Color fundus photograph; 2346x1568px:
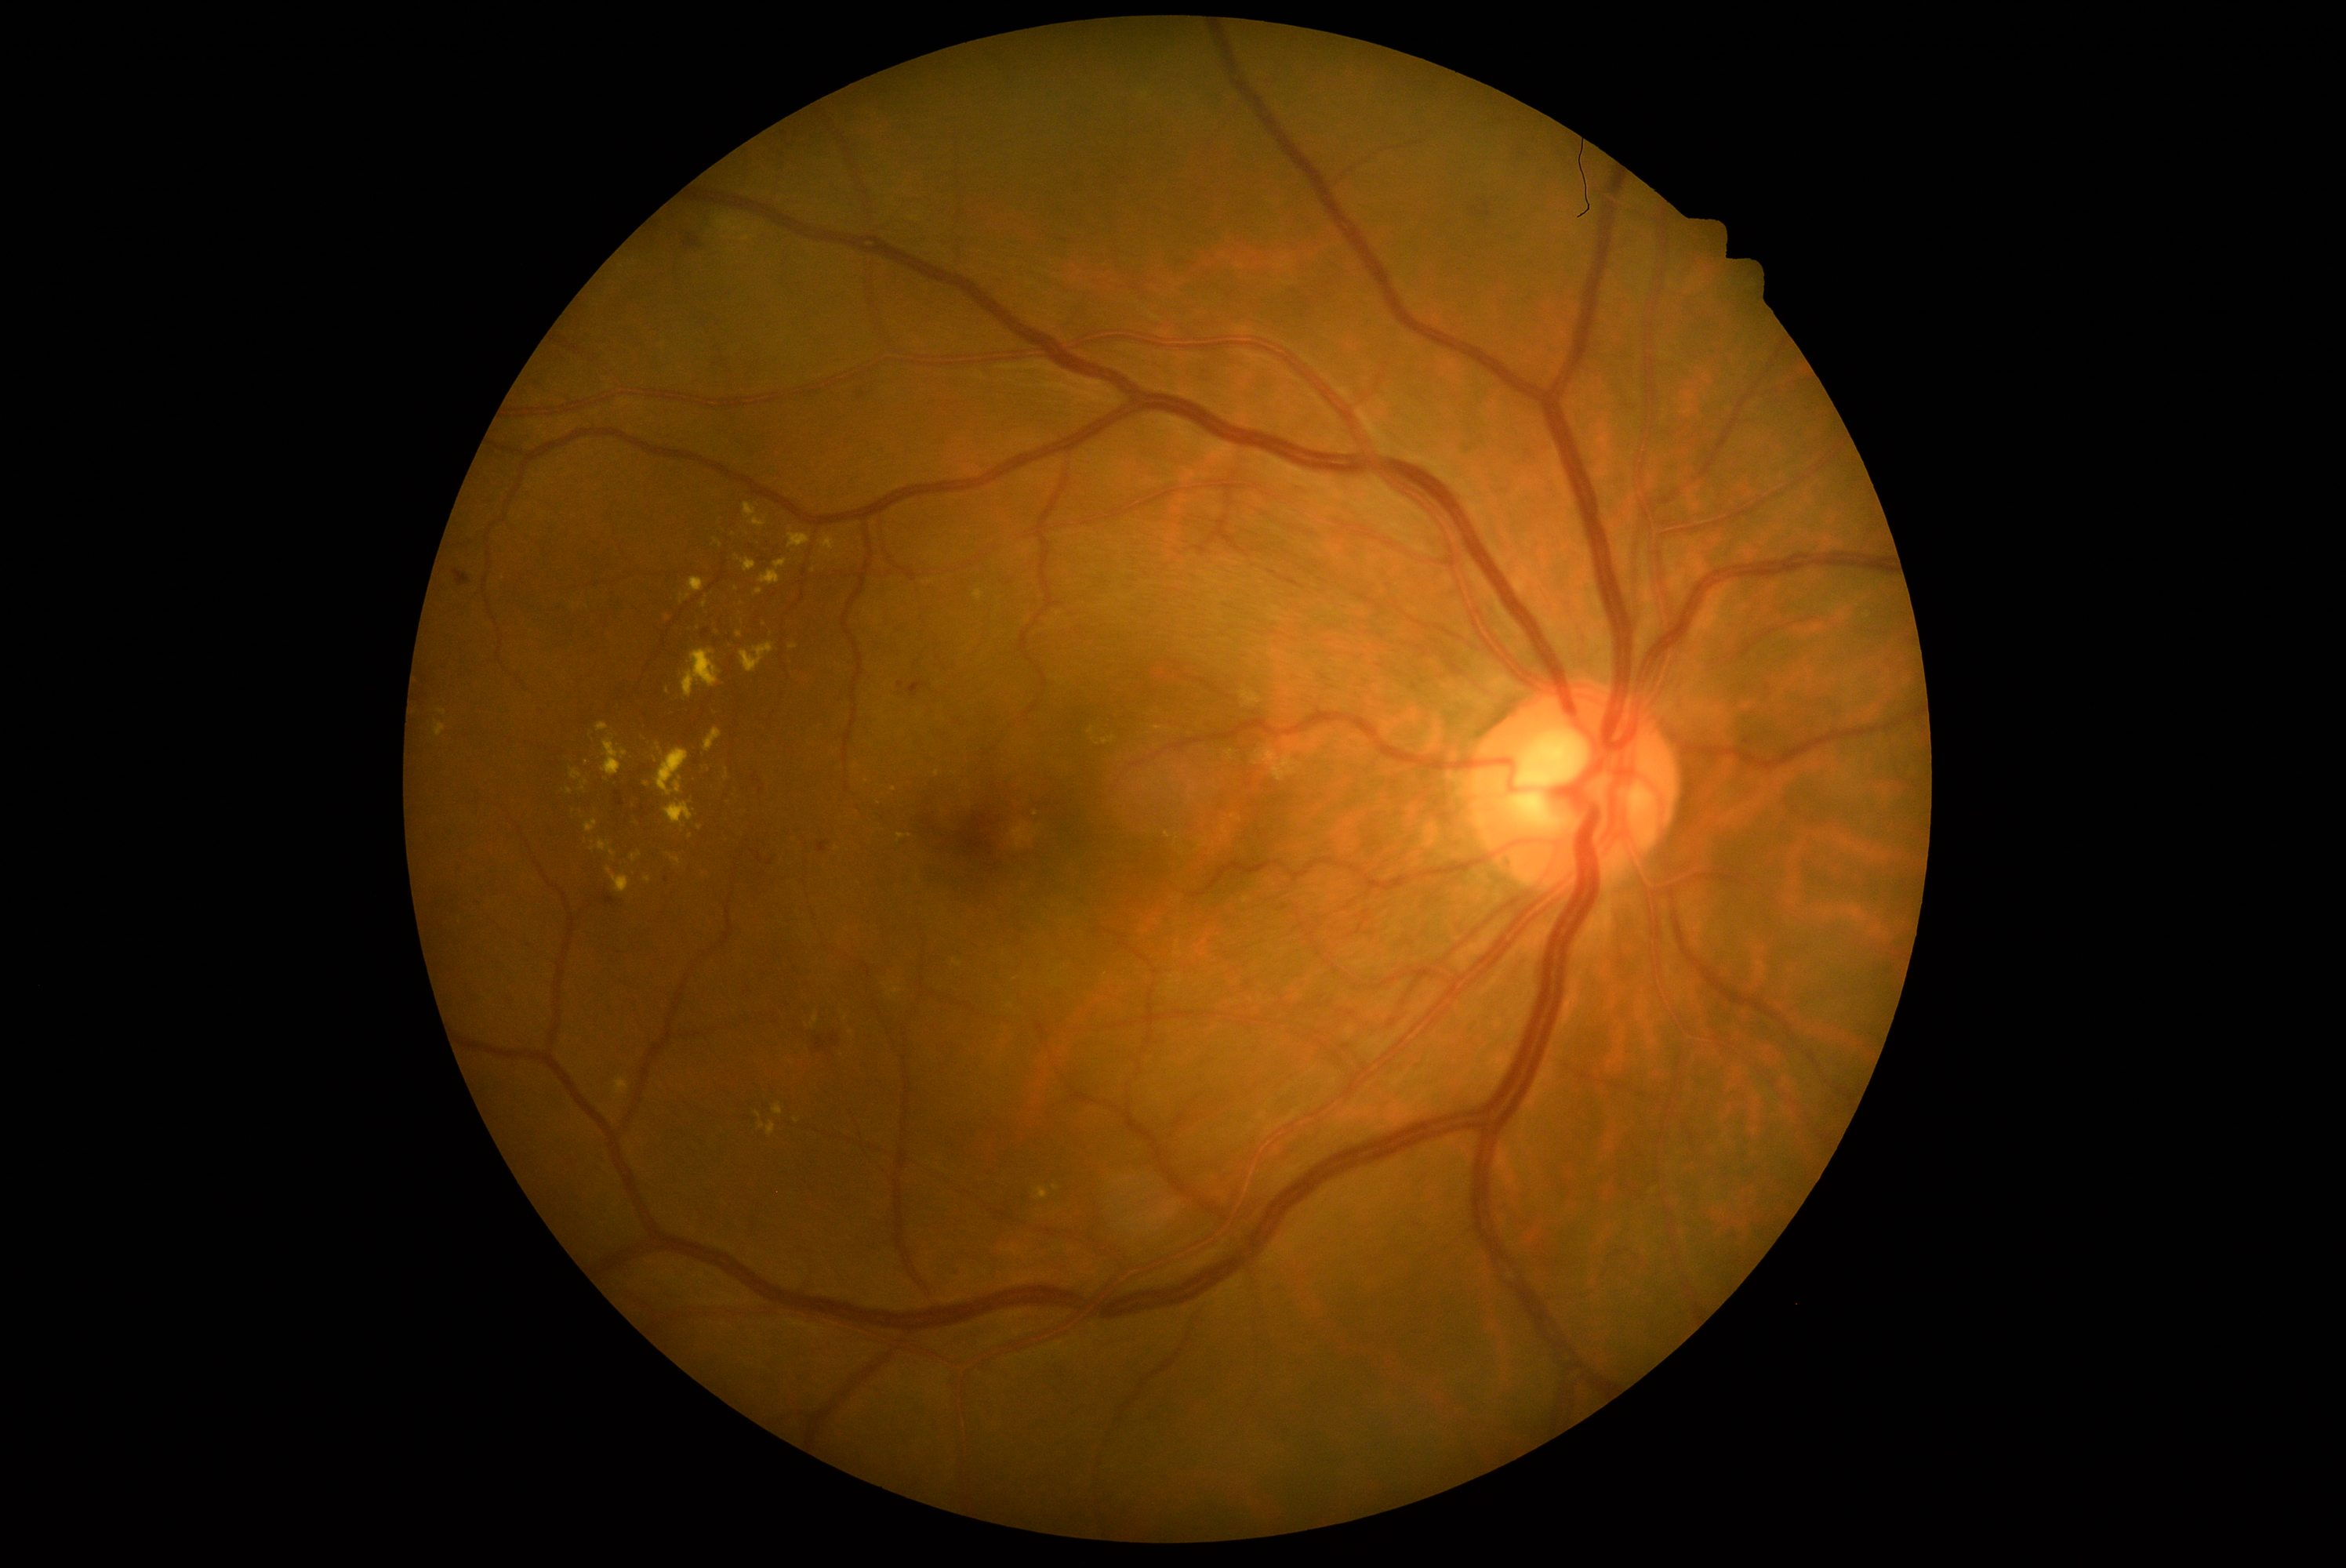

Diabetic retinopathy (DR): 2 — more than just microaneurysms but less than severe NPDR
A subset of detected lesions:
hemorrhages (HEs) = bbox(857, 391, 865, 399), bbox(907, 681, 929, 699), bbox(683, 234, 700, 249), bbox(614, 793, 625, 807), bbox(818, 841, 830, 854), bbox(703, 630, 710, 639), bbox(815, 1036, 838, 1053), bbox(601, 891, 617, 909), bbox(757, 852, 763, 863), bbox(898, 681, 904, 689), bbox(719, 634, 732, 644), bbox(752, 775, 760, 783), bbox(454, 570, 471, 587), bbox(713, 641, 717, 653)
Small HEs near <point>762, 791</point>, <point>642, 808</point>, <point>769, 863</point>
hard exudates (EXs) (continued) = bbox(681, 648, 722, 699), bbox(758, 1123, 775, 1138), bbox(663, 684, 670, 695), bbox(664, 802, 694, 829), bbox(874, 797, 882, 805), bbox(572, 769, 581, 780), bbox(772, 1105, 783, 1116), bbox(438, 710, 446, 716), bbox(813, 1015, 819, 1023), bbox(1036, 1188, 1048, 1200), bbox(744, 504, 768, 528)
Small EXs near <point>836, 849</point>, <point>740, 636</point>, <point>699, 828</point>, <point>696, 627</point>, <point>937, 774</point>
soft exudates (SEs) = none detected
microaneurysms (MAs) = none detected